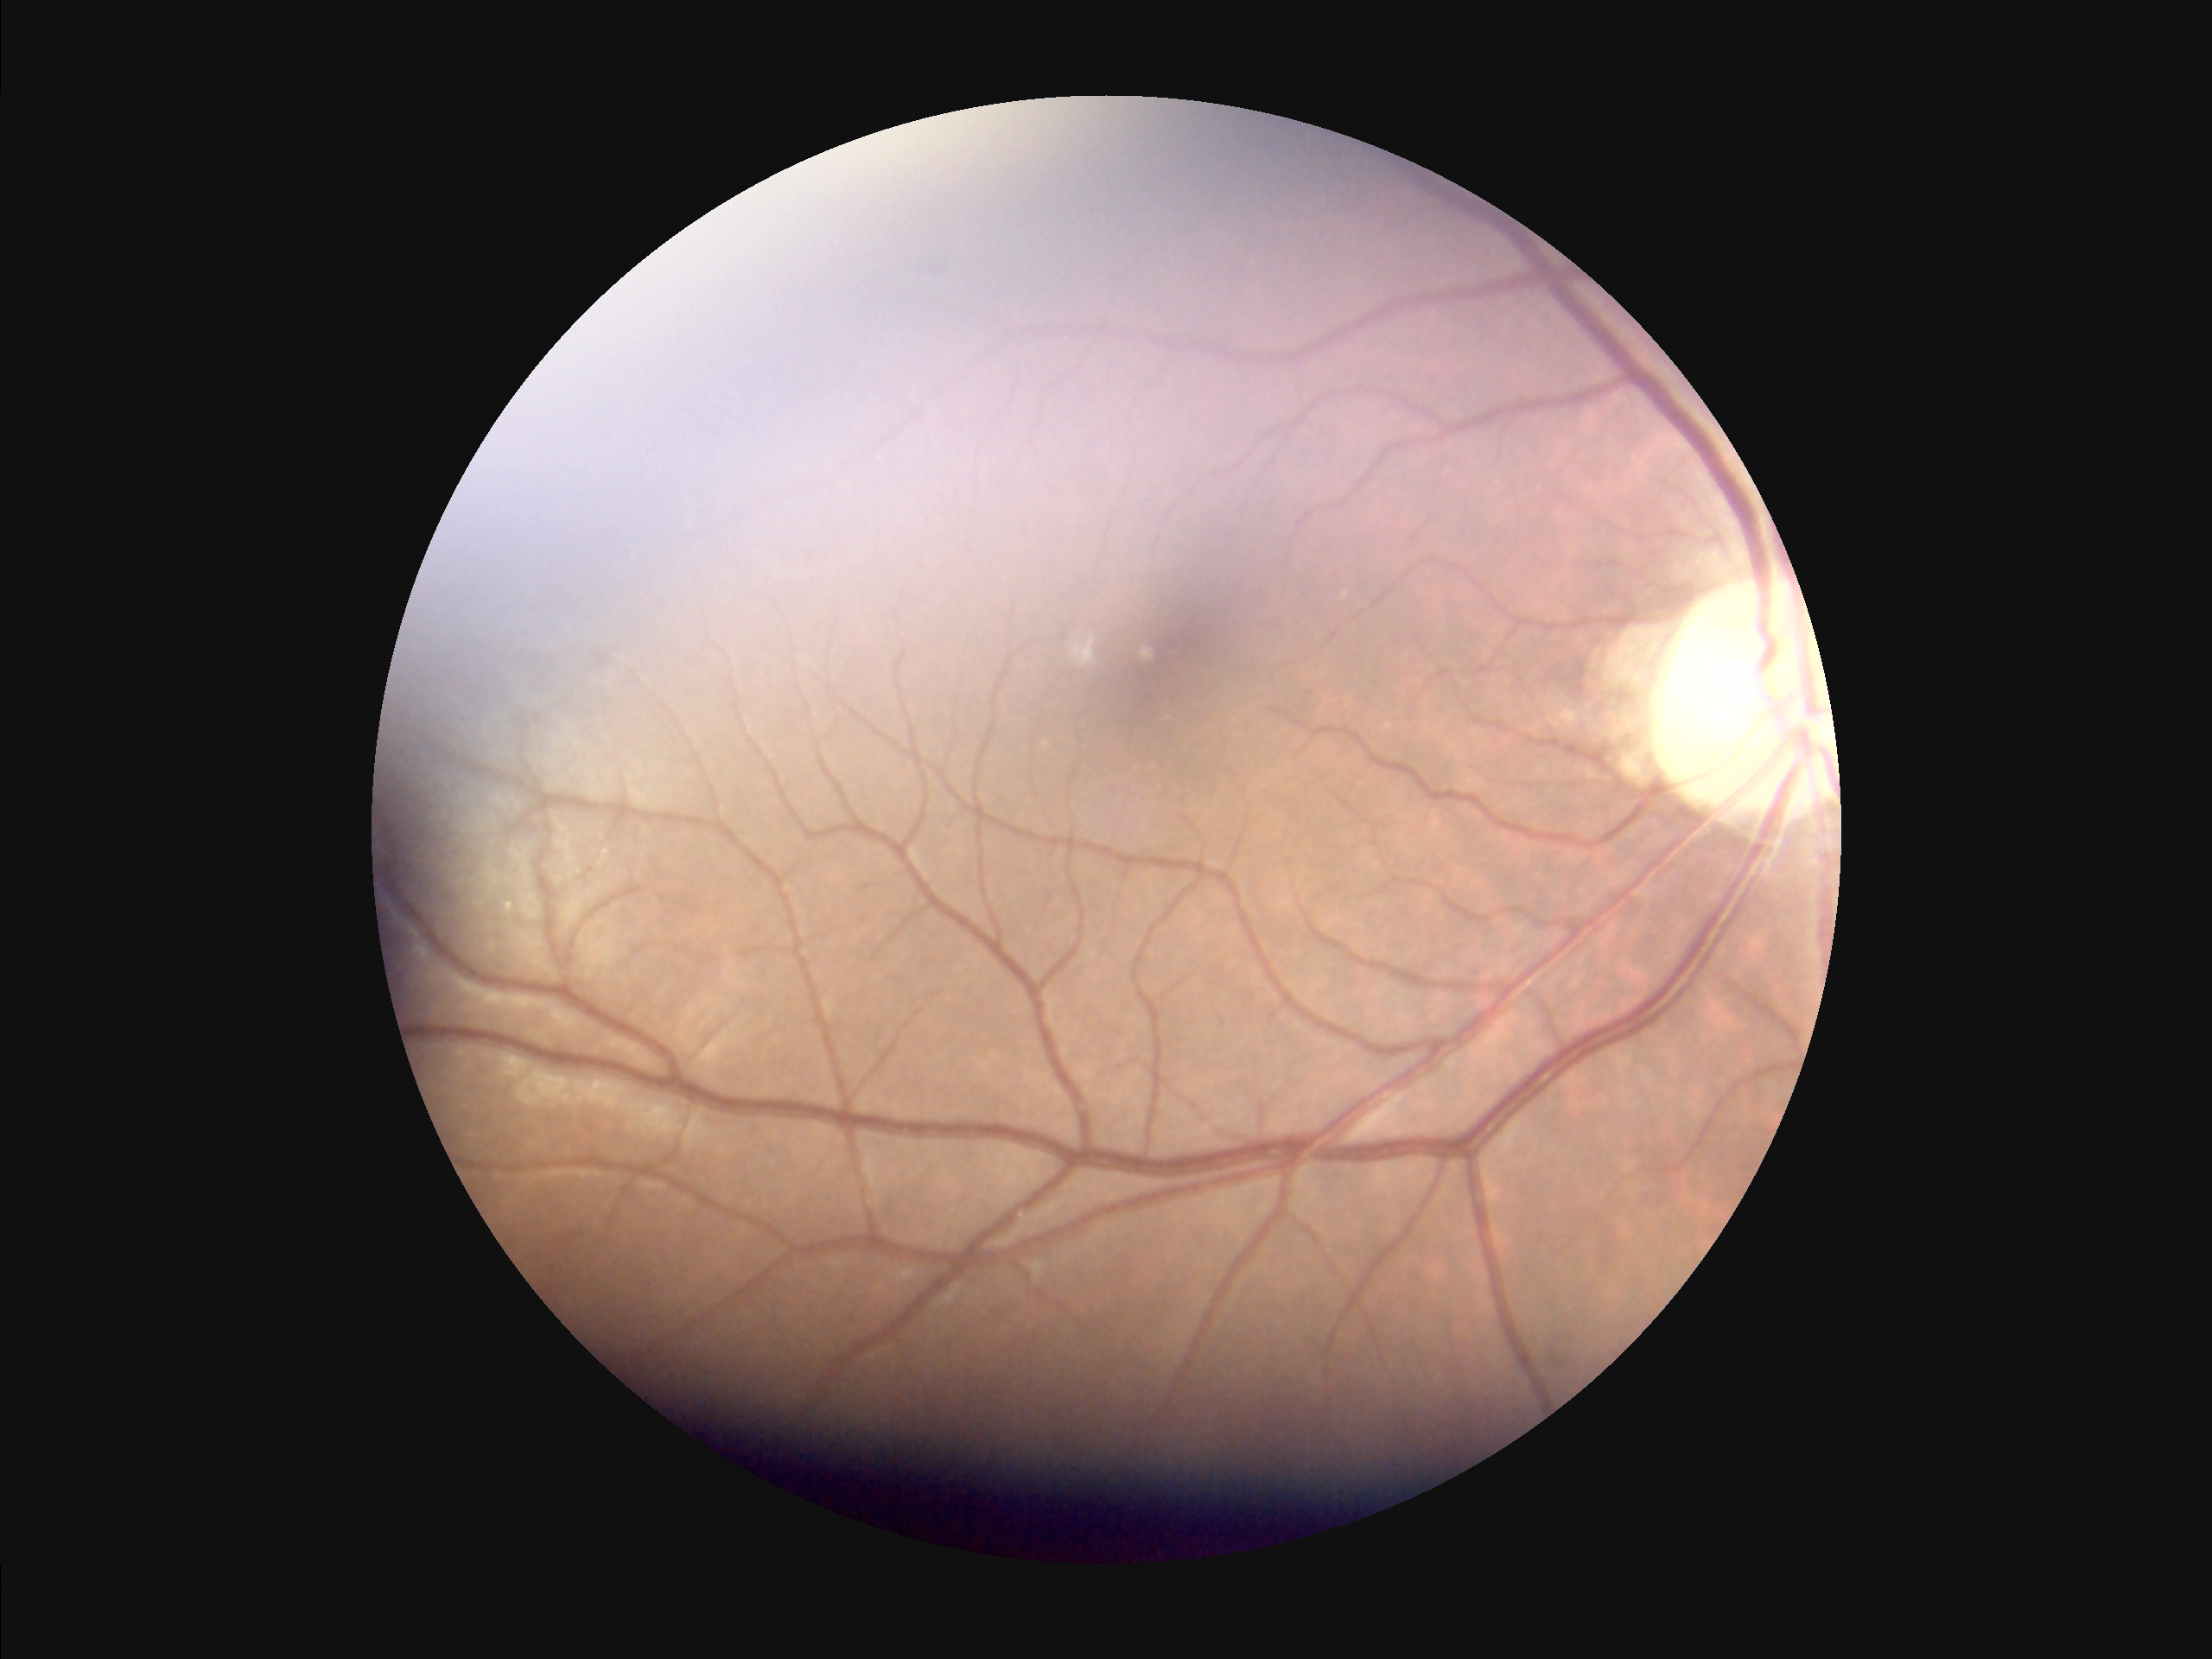

Contrast = poor dynamic range
Overall image quality = inadequate for clinical interpretation
Illumination = uneven illumination or color cast
Focus = noticeable blur in the optic disc, vessels, or background